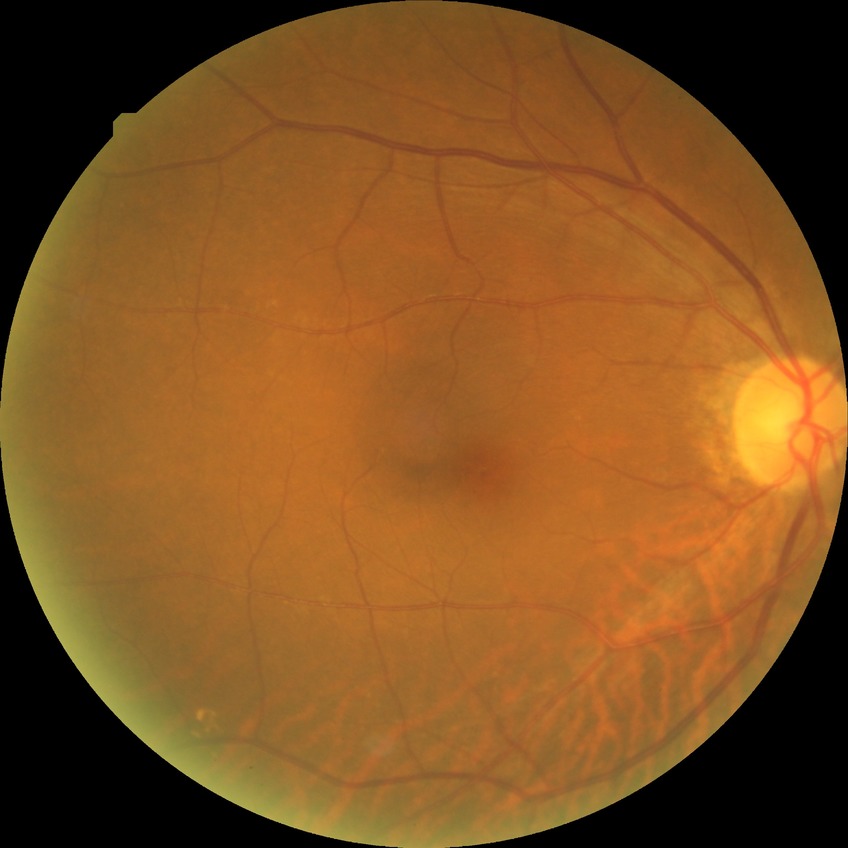
diabetic retinopathy (DR) = no diabetic retinopathy (NDR).